Modified Davis grading. CFP — 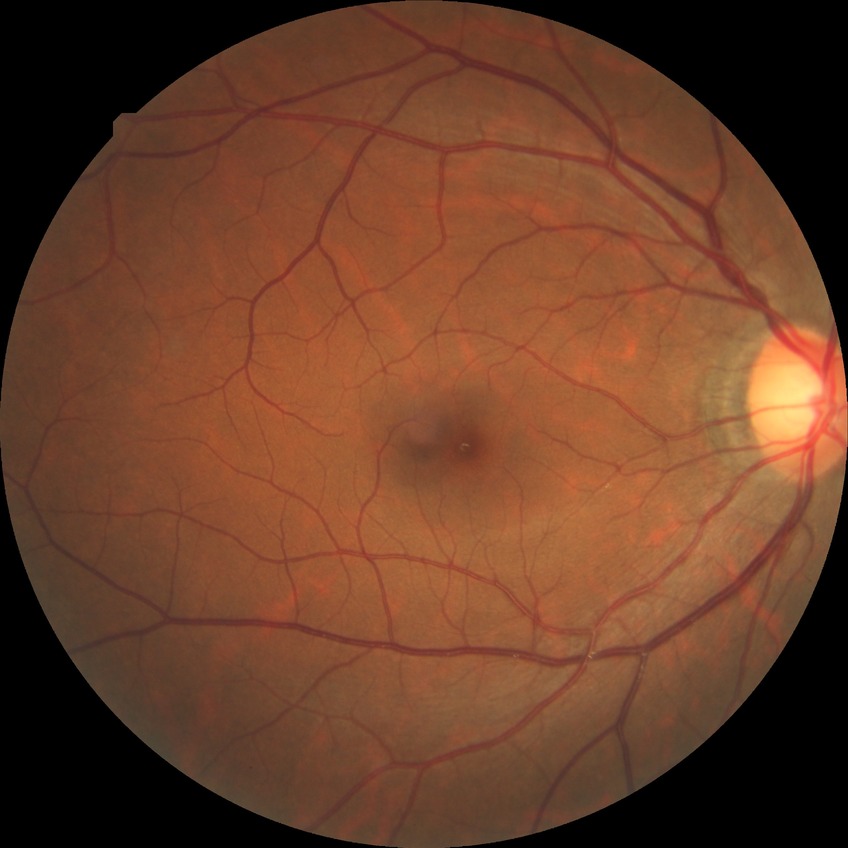
DR impression=no apparent DR; DR grade=NDR.